FOV: 45 degrees: 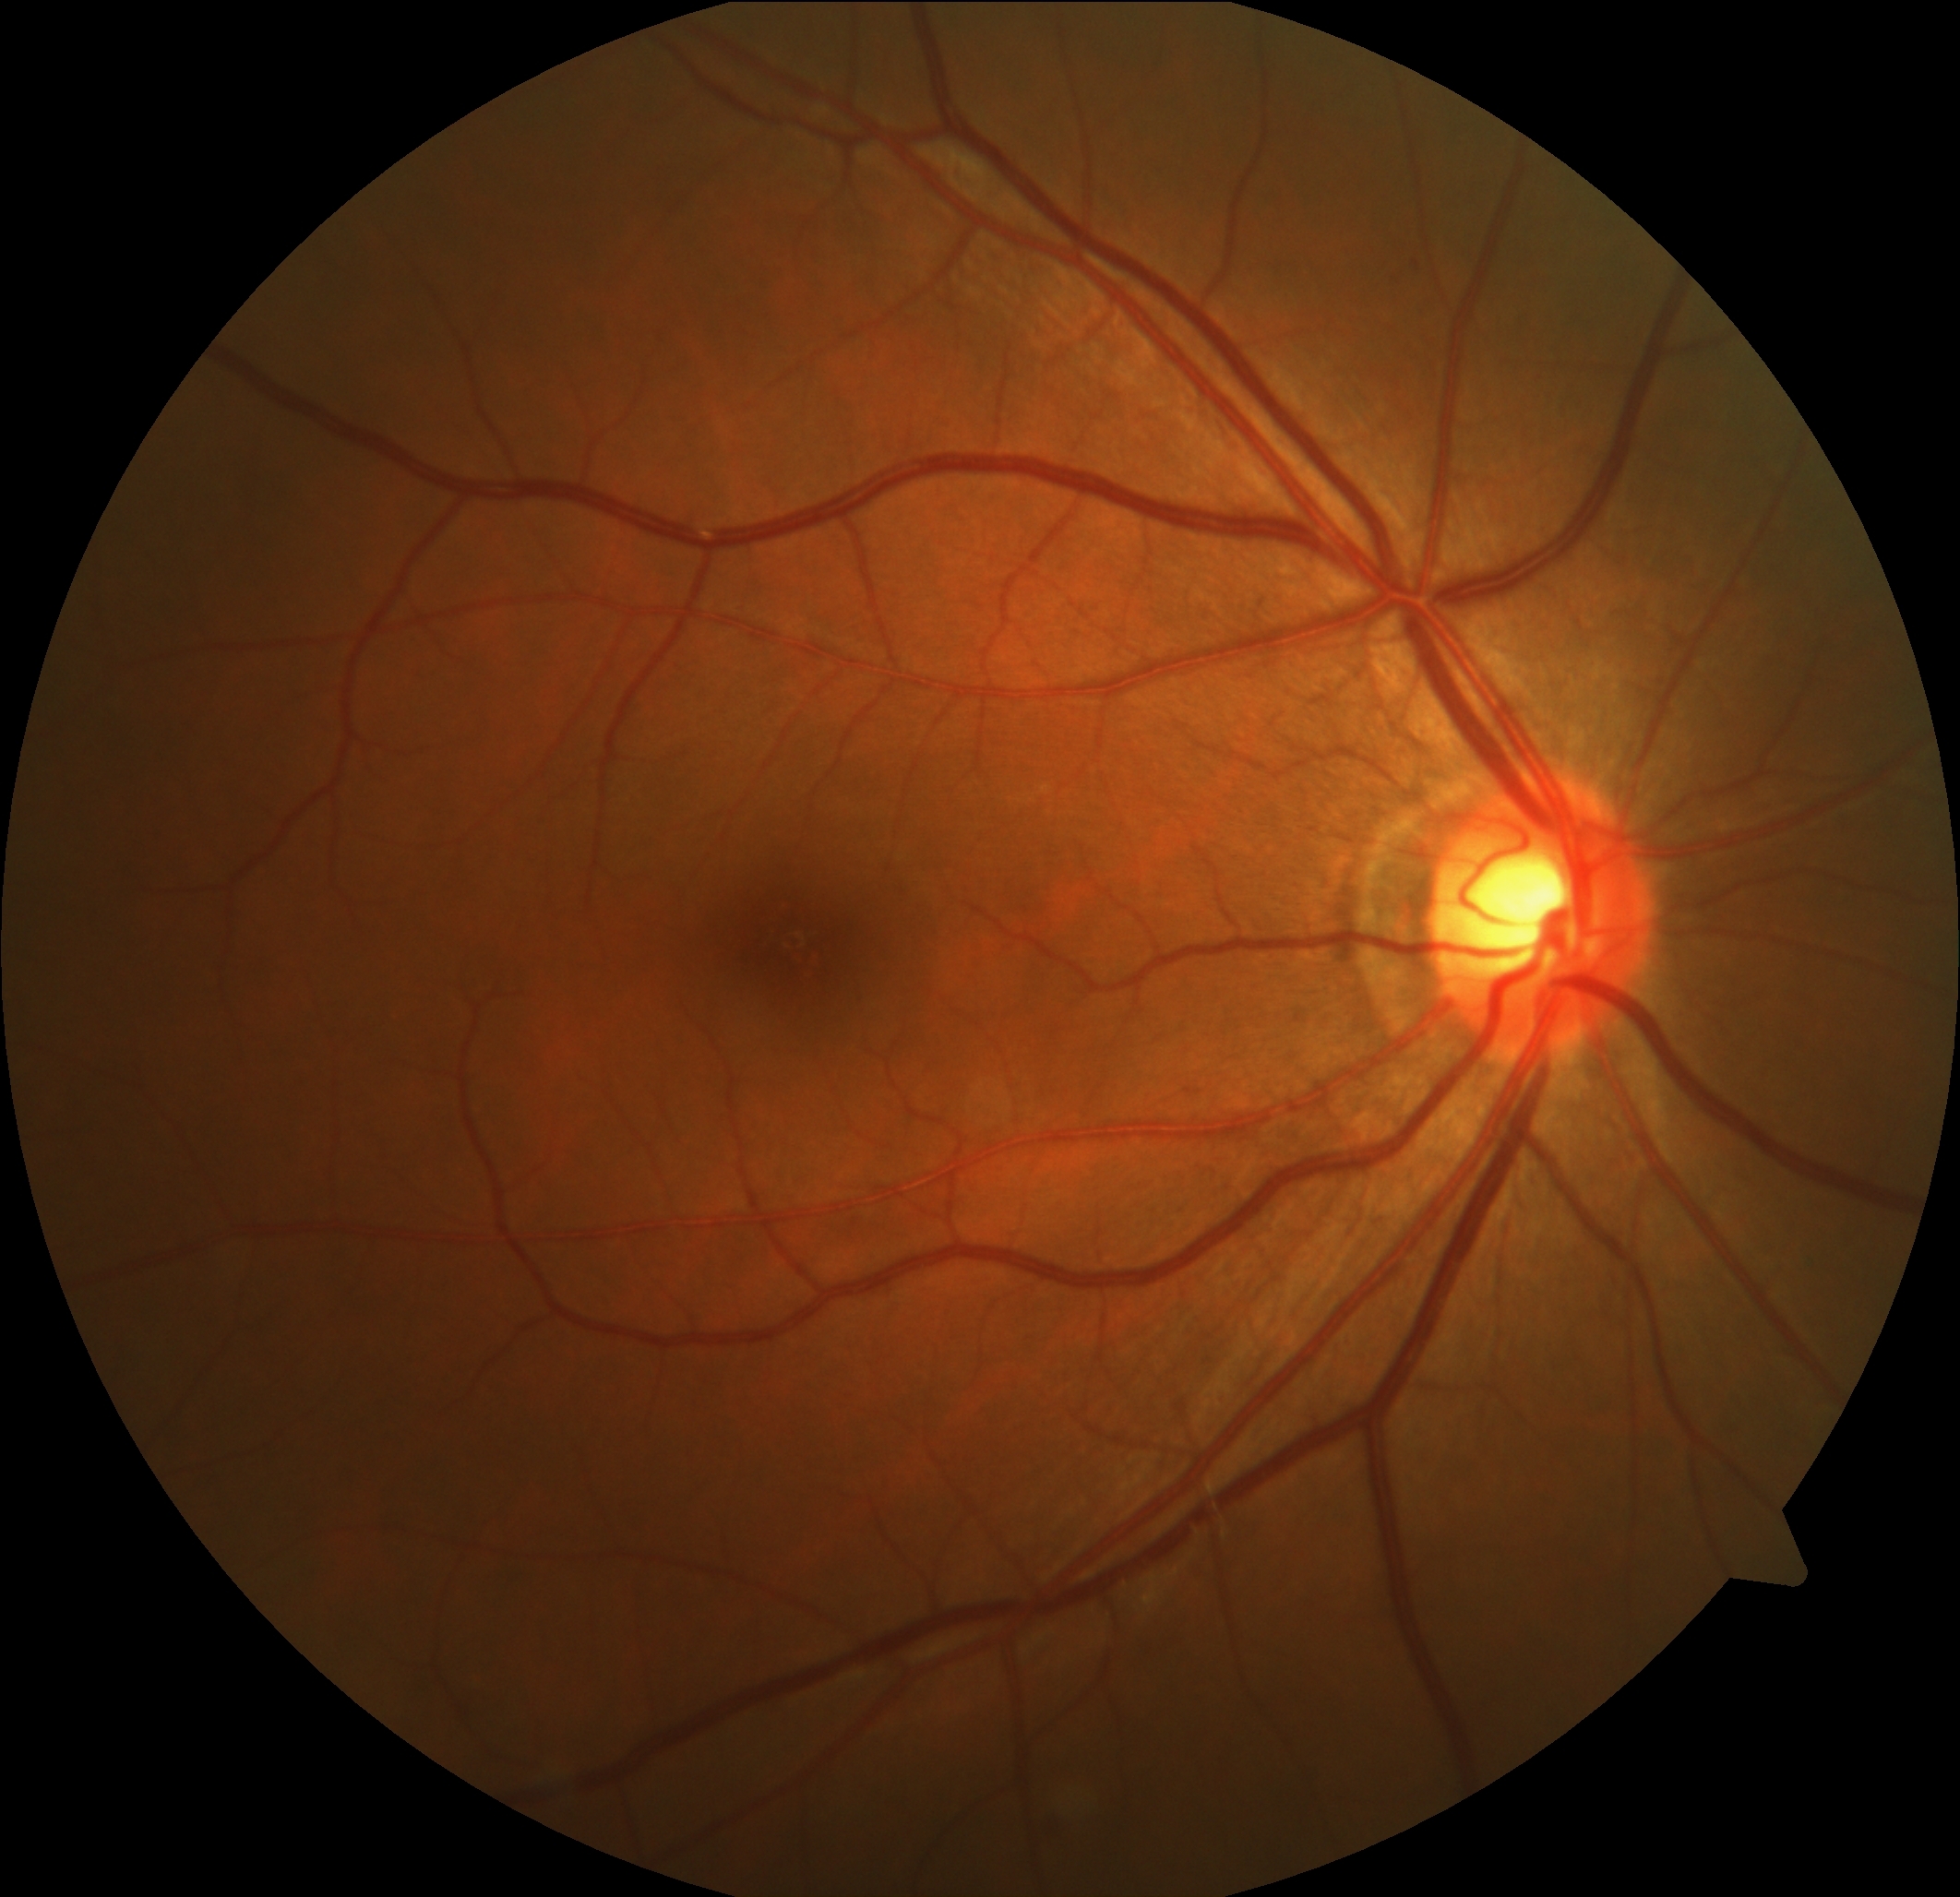 • DR grade — no apparent diabetic retinopathy (0)